Retinal fundus photograph. 45° field of view — 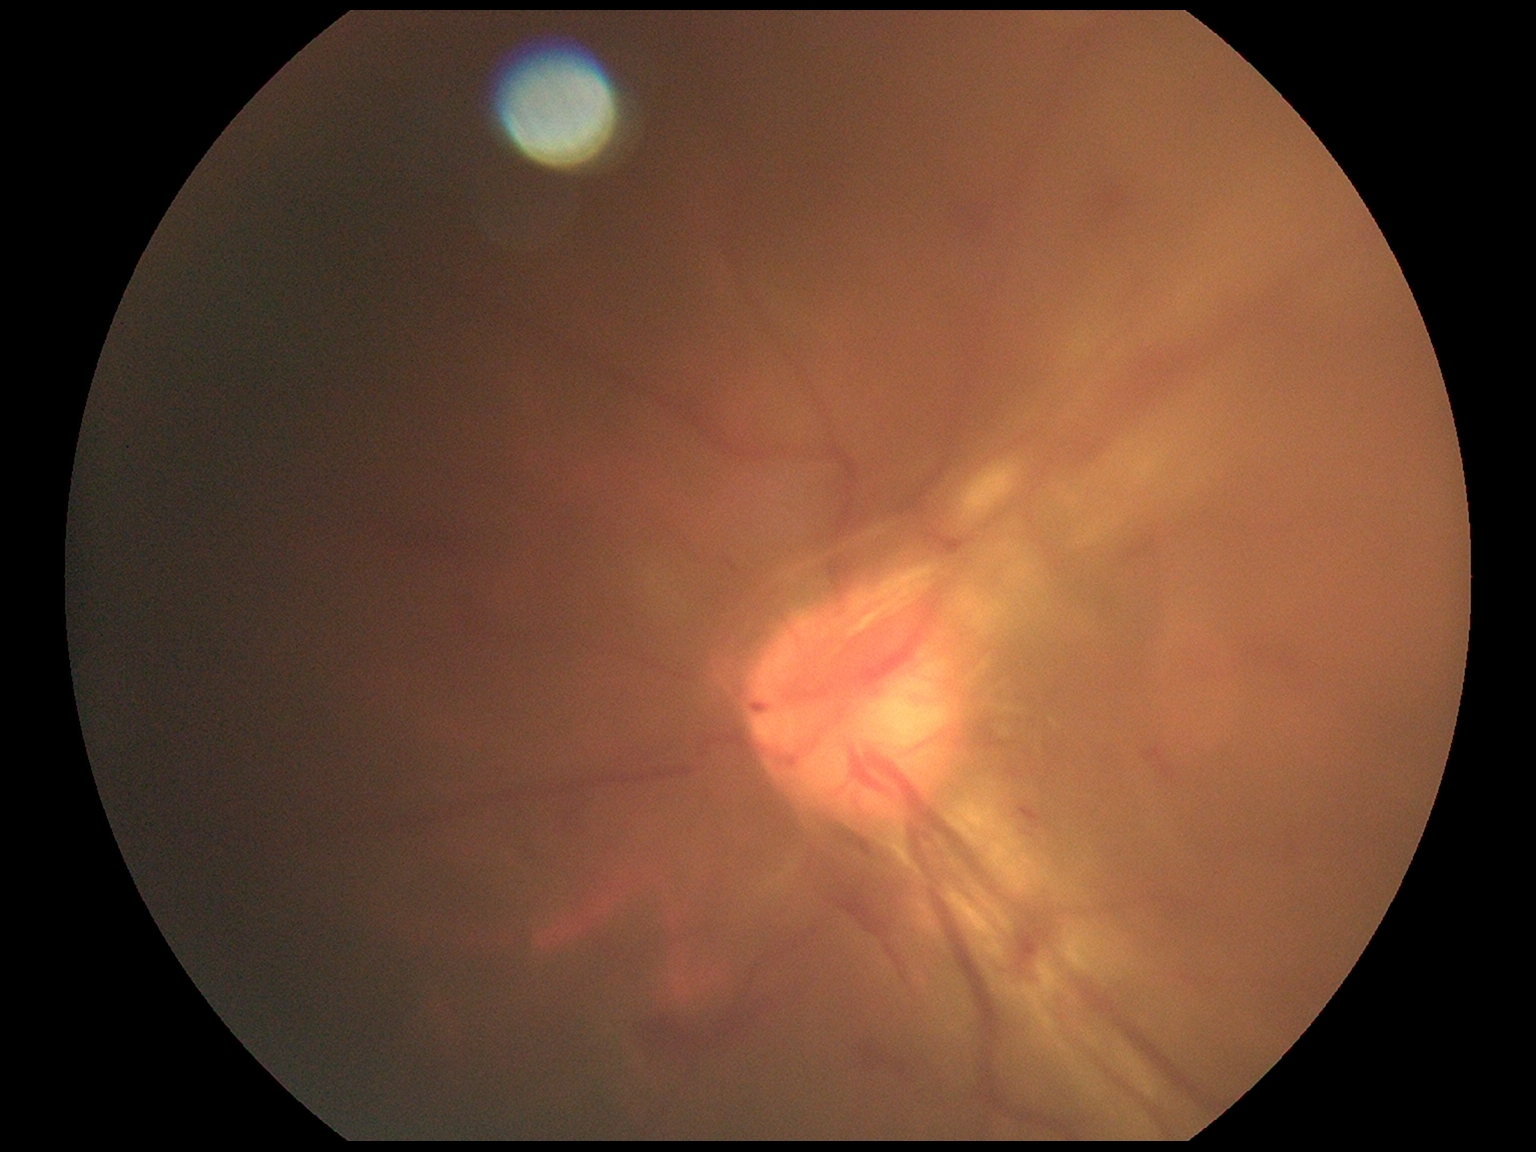
Findings:
- DR: 4/4